Modified Davis grading: 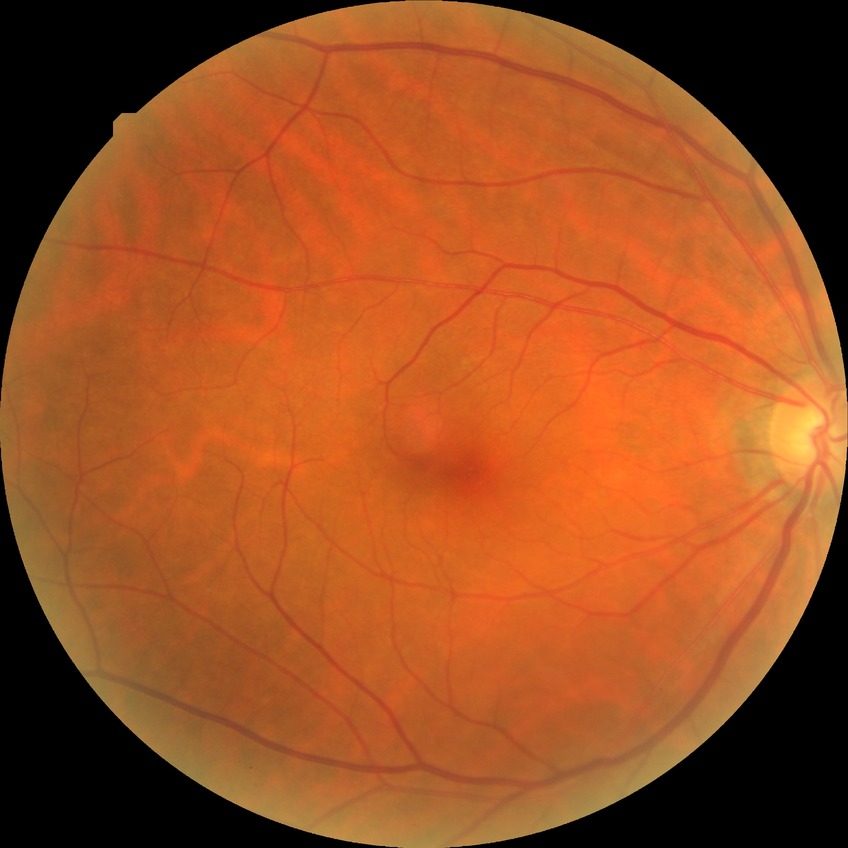

Diabetic retinopathy severity: no diabetic retinopathy.